45-degree field of view — 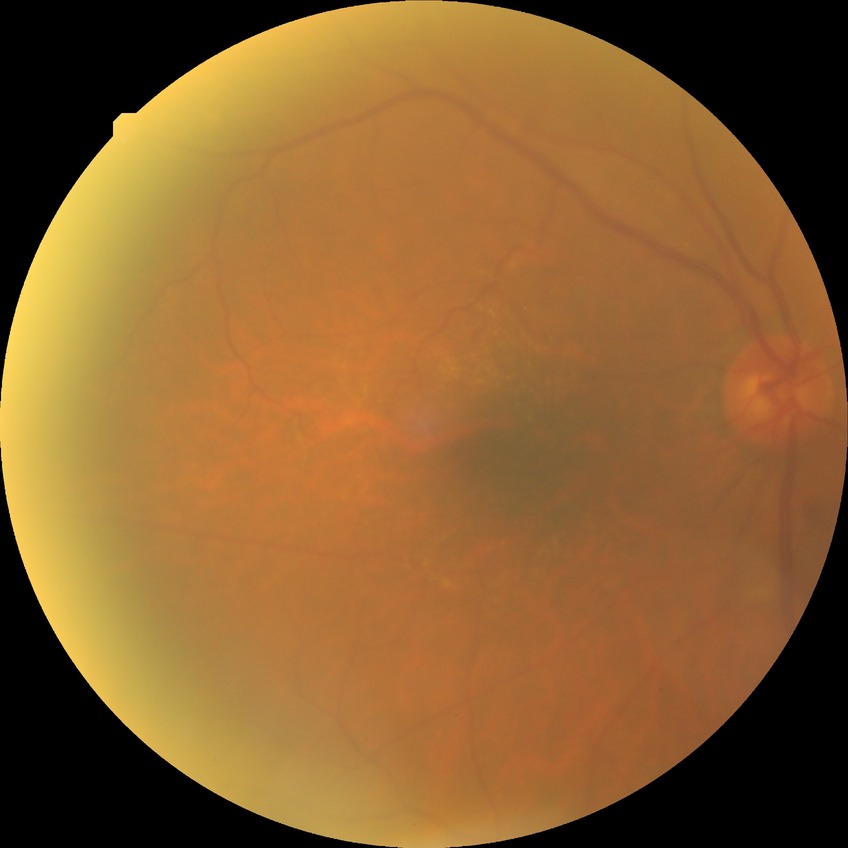
Diabetic retinopathy (DR): simple diabetic retinopathy (SDR).
DR class: non-proliferative diabetic retinopathy.